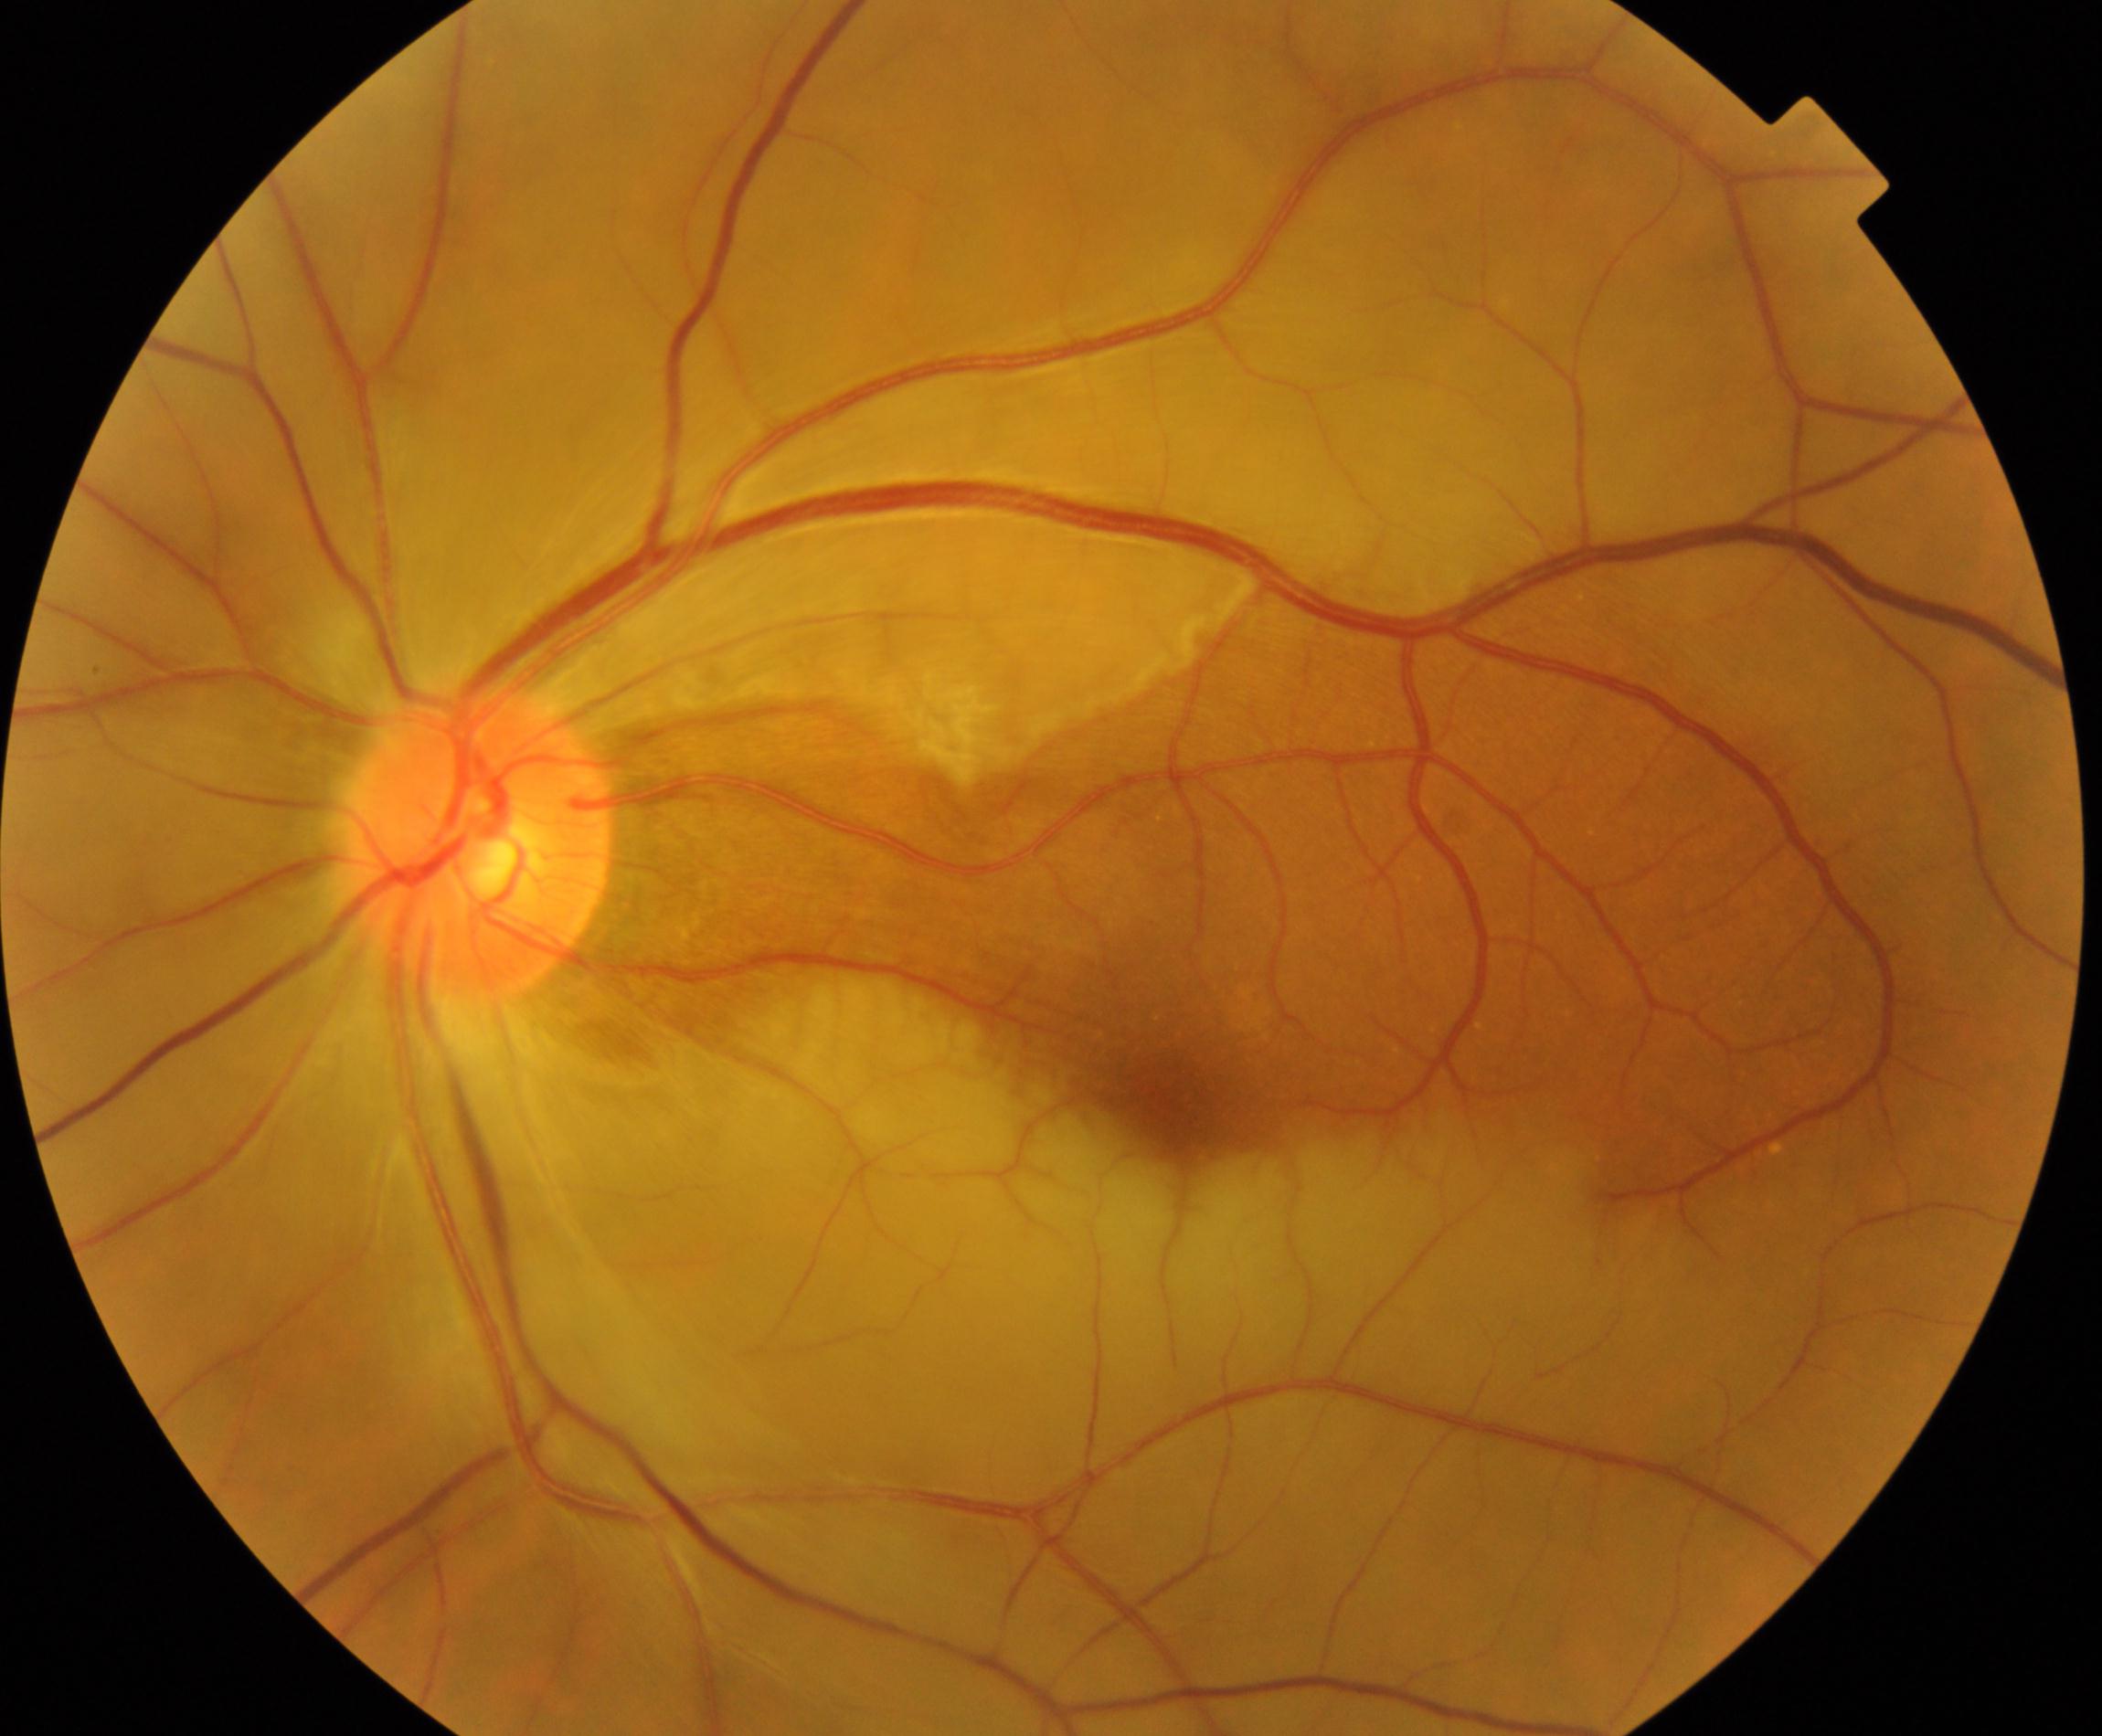

Primary finding: RAO (retinal artery occlusion).